Modified Davis classification · posterior pole photograph · NIDEK AFC-230 fundus camera: 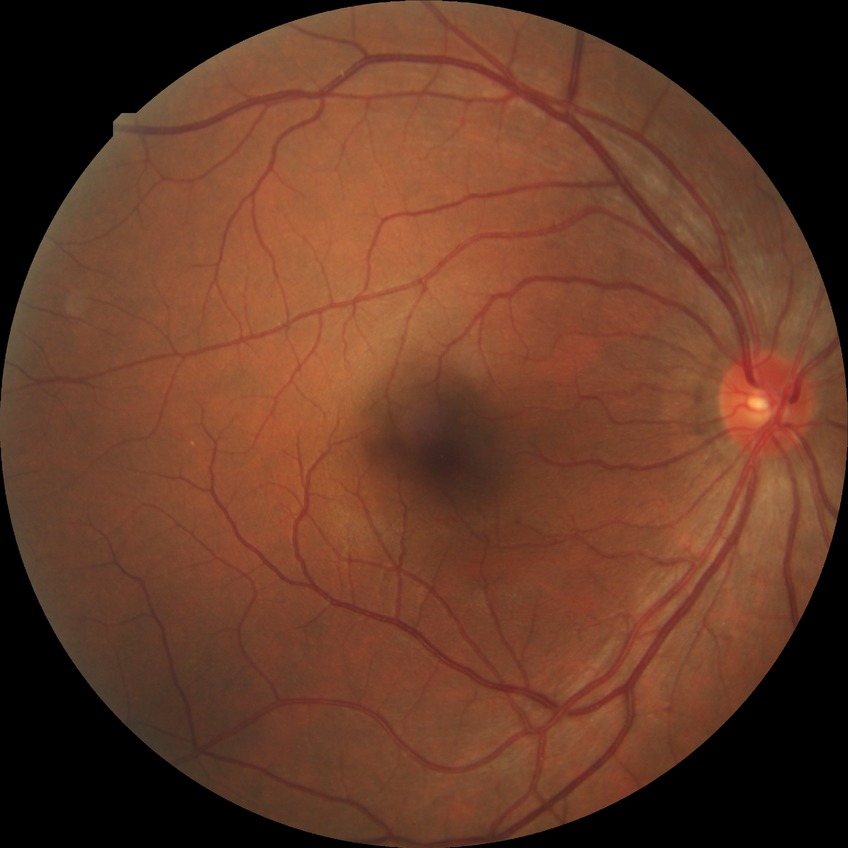

Davis stage: NDR. No DR findings.